45° FOV:
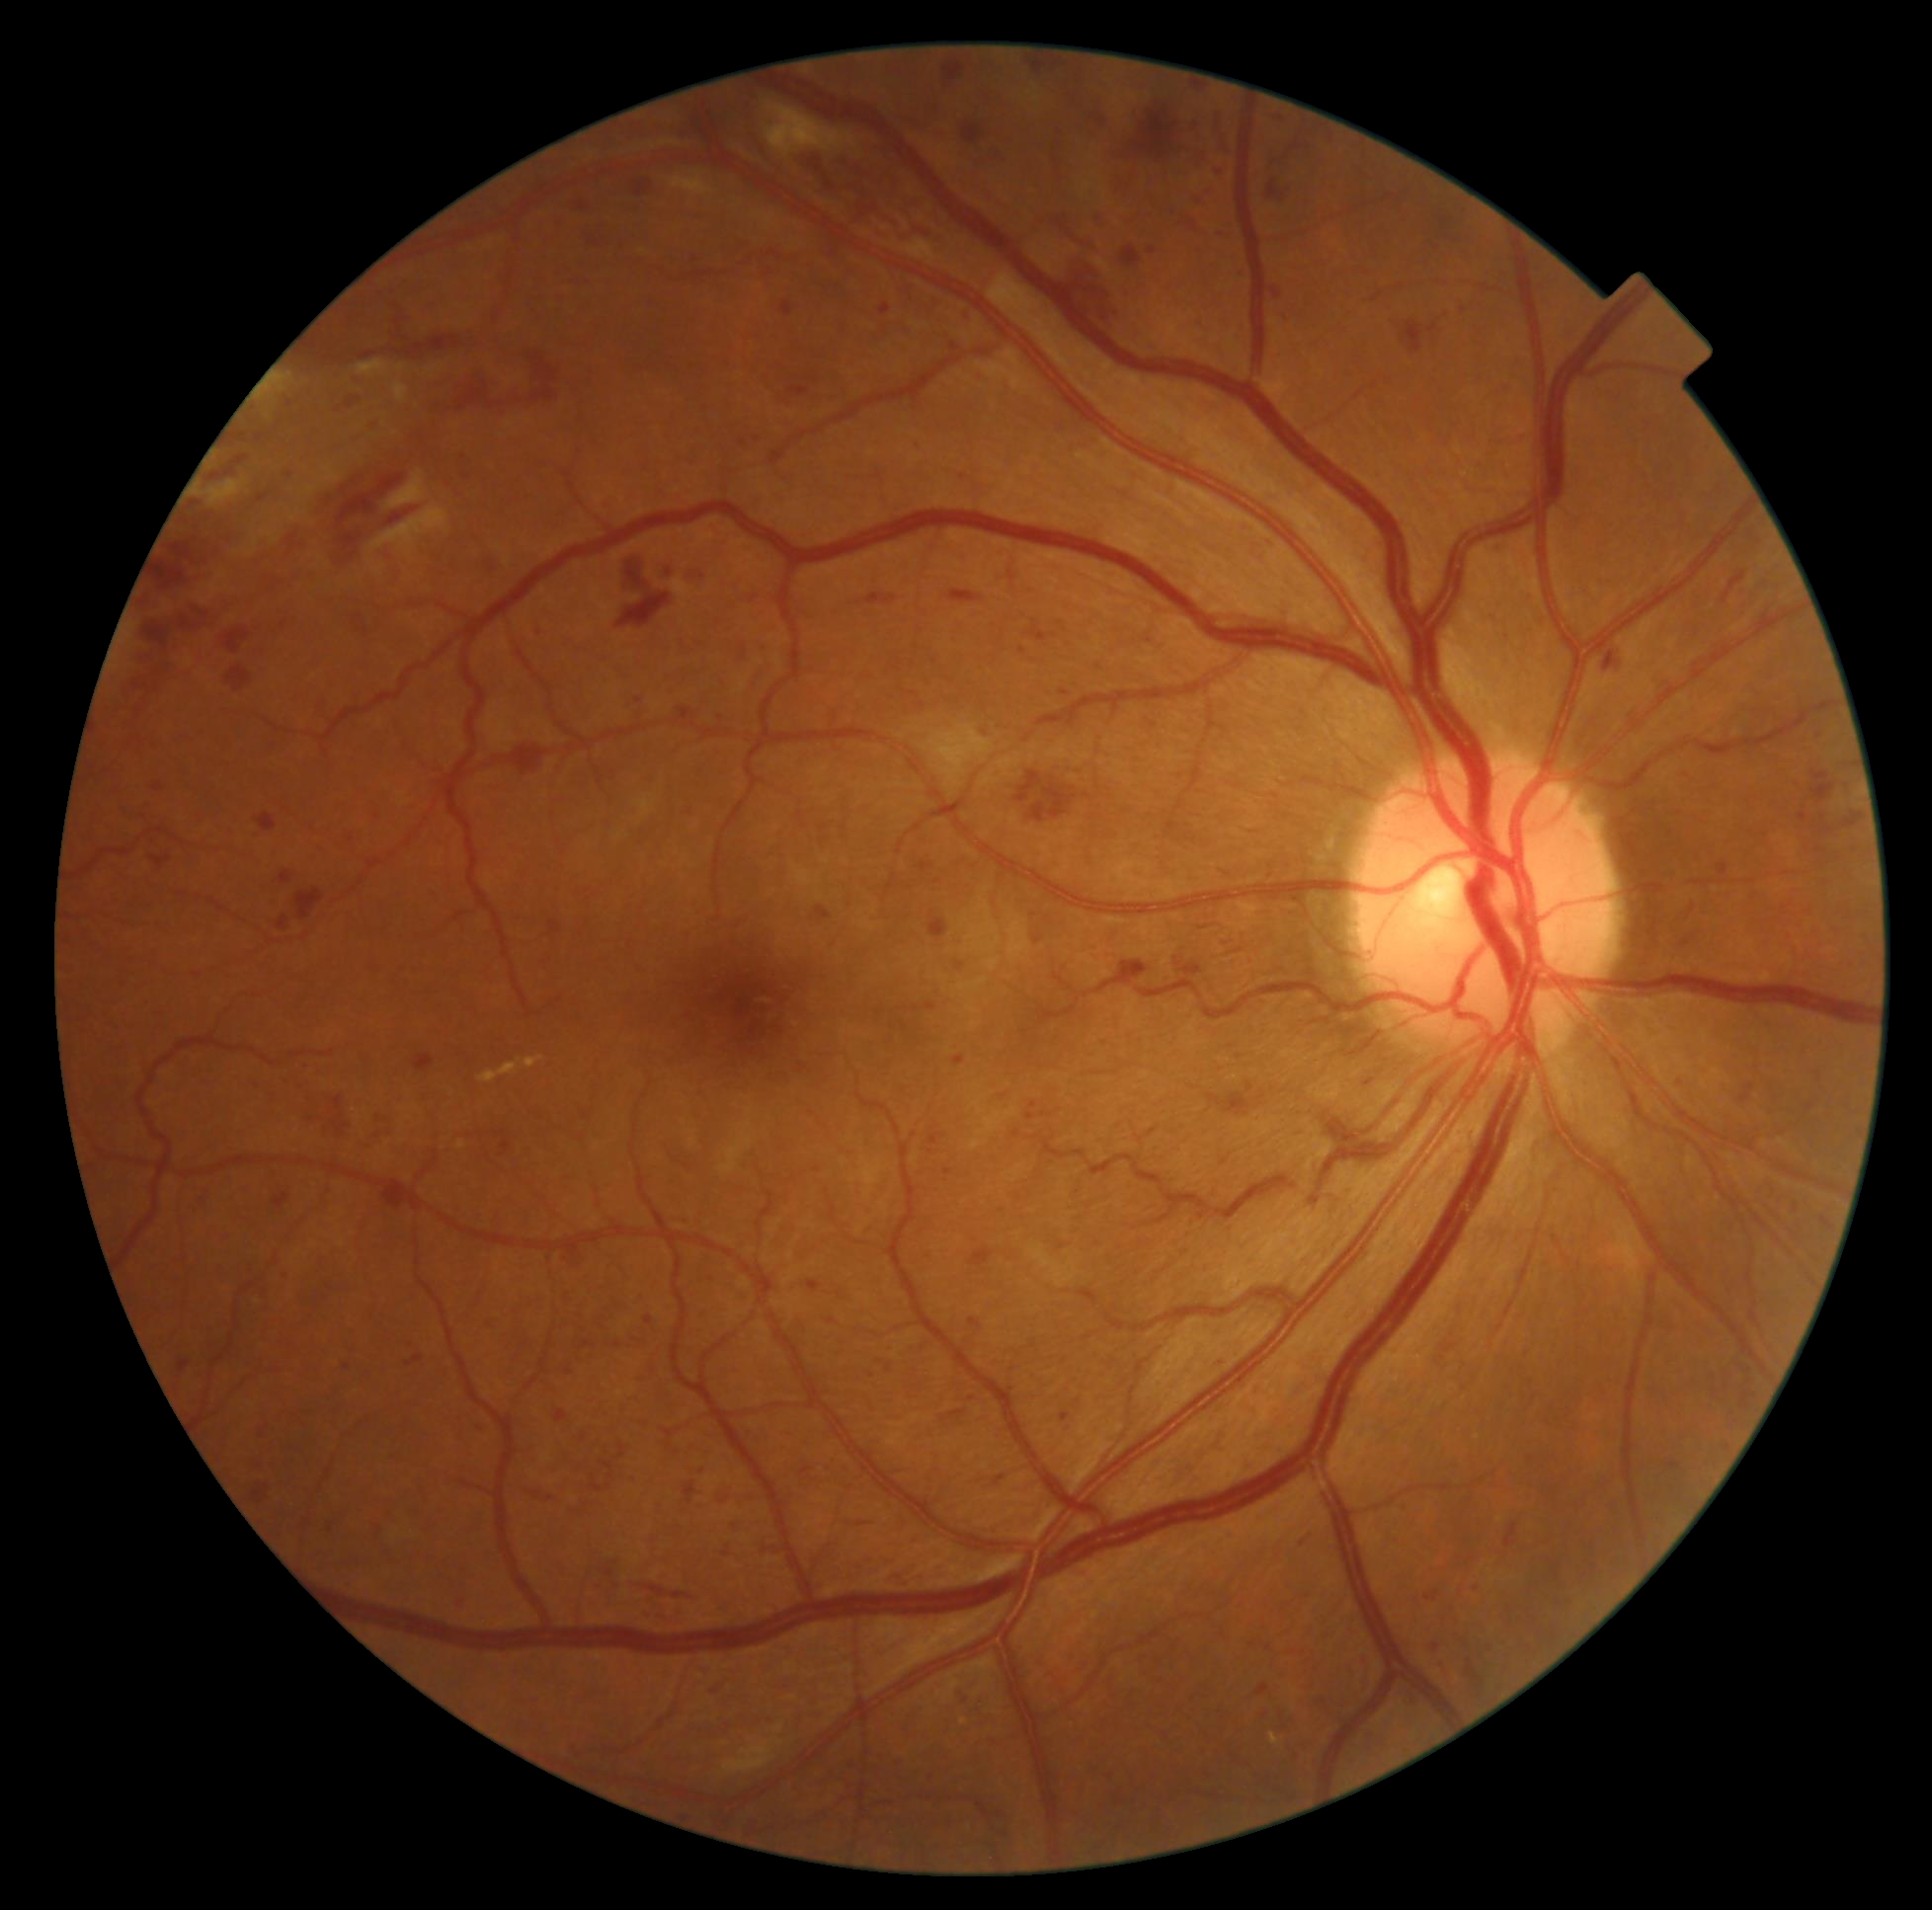

DR class@non-proliferative diabetic retinopathy; diabetic retinopathy (DR)@severe NPDR (grade 3).